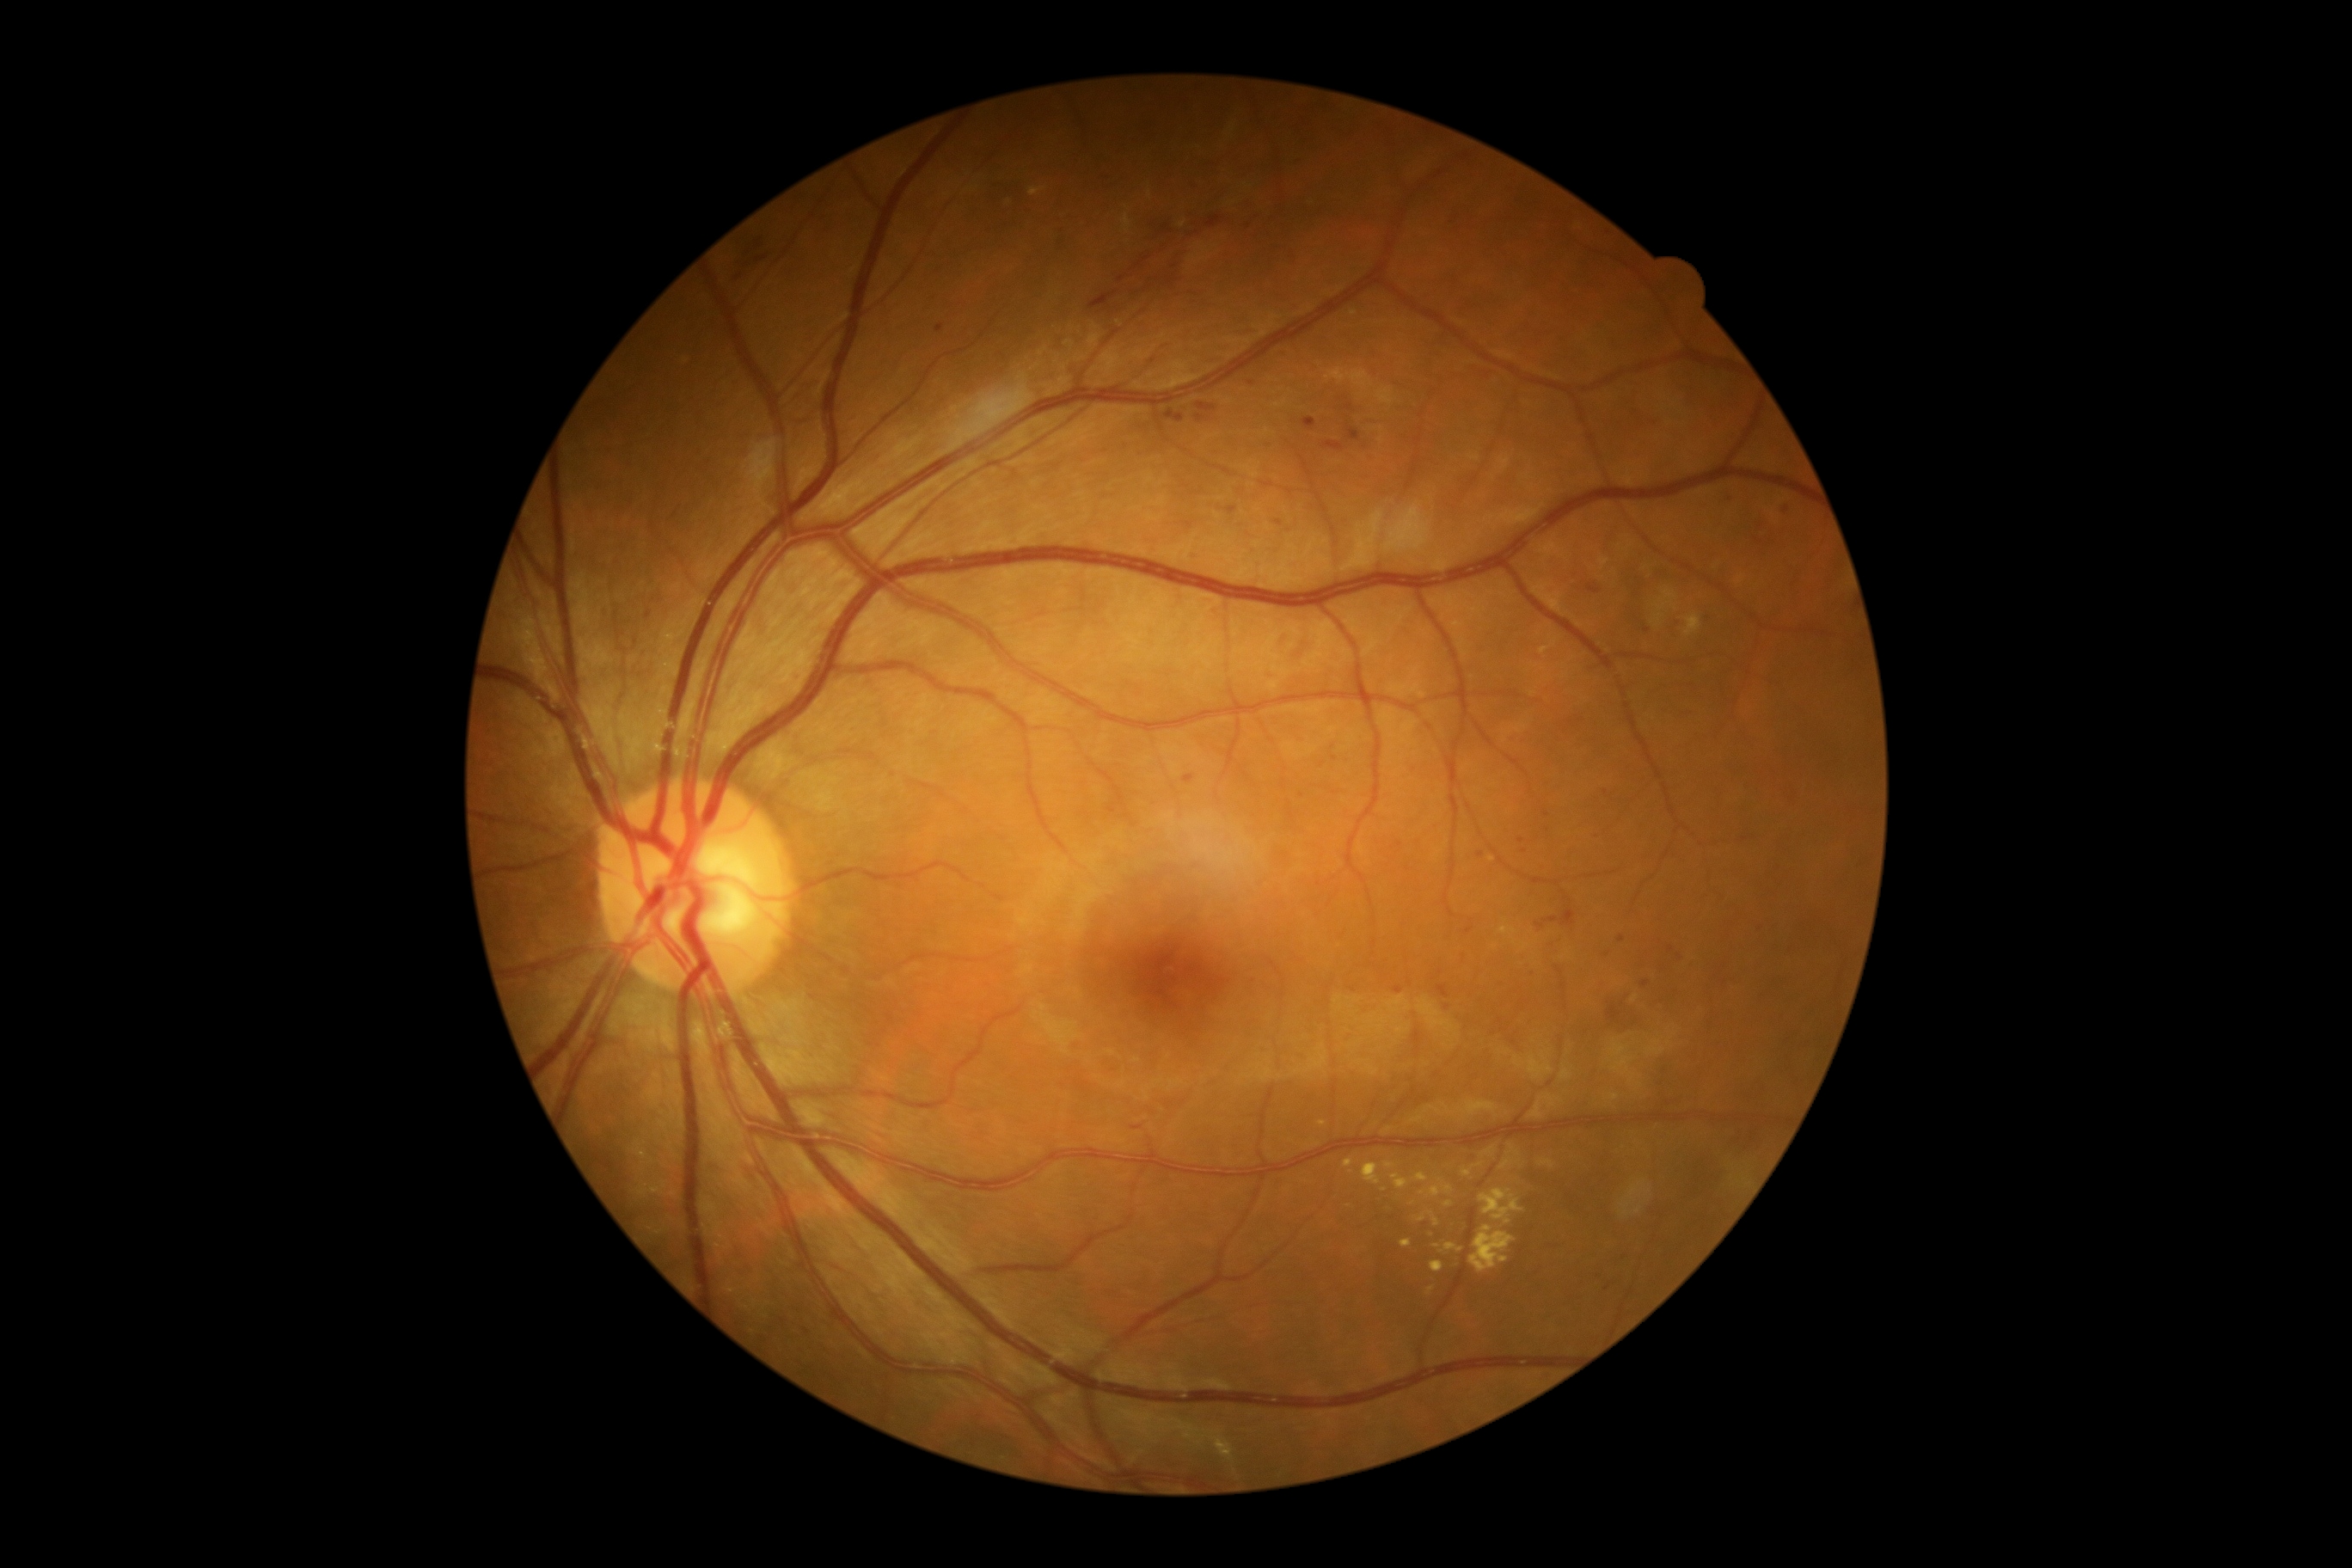 Diabetic retinopathy (DR): grade 2 (moderate NPDR); non-proliferative diabetic retinopathy
Selected lesions:
• soft exudates (SEs): none detected
• microaneurysms (MAs) (partial): 1134:1125:1142:1130; 1536:909:1577:929; 1287:809:1295:821; 936:326:943:334; 1347:427:1361:443; 644:609:652:618; 1436:984:1449:998; 1641:981:1650:988; 1588:582:1602:596
• Smaller MAs around (1366; 448); (1679; 957); (1521; 840); (1447; 1007); (1348; 407); (1622; 939); (1622; 1005)
• hemorrhages (HEs): 1089:228:1189:310; 1196:403:1216:413; 1196:413:1206:422; 1206:216:1223:228; 728:240:776:288; 1165:410:1185:422
• hard exudates (EXs) (partial): 1500:1144:1521:1170; 1414:1173:1428:1182; 1385:1163:1395:1170; 1471:1225:1516:1273; 1363:1163:1381:1185; 1421:1187:1442:1197; 1462:1163:1483:1177; 1433:1246:1442:1249; 1431:1261:1445:1273; 1400:1239:1412:1247; 1445:1203:1454:1208; 1426:1287:1435:1297
• Smaller EXs around (1349; 1206)